45-degree field of view; fundus photo; 2212x1659px
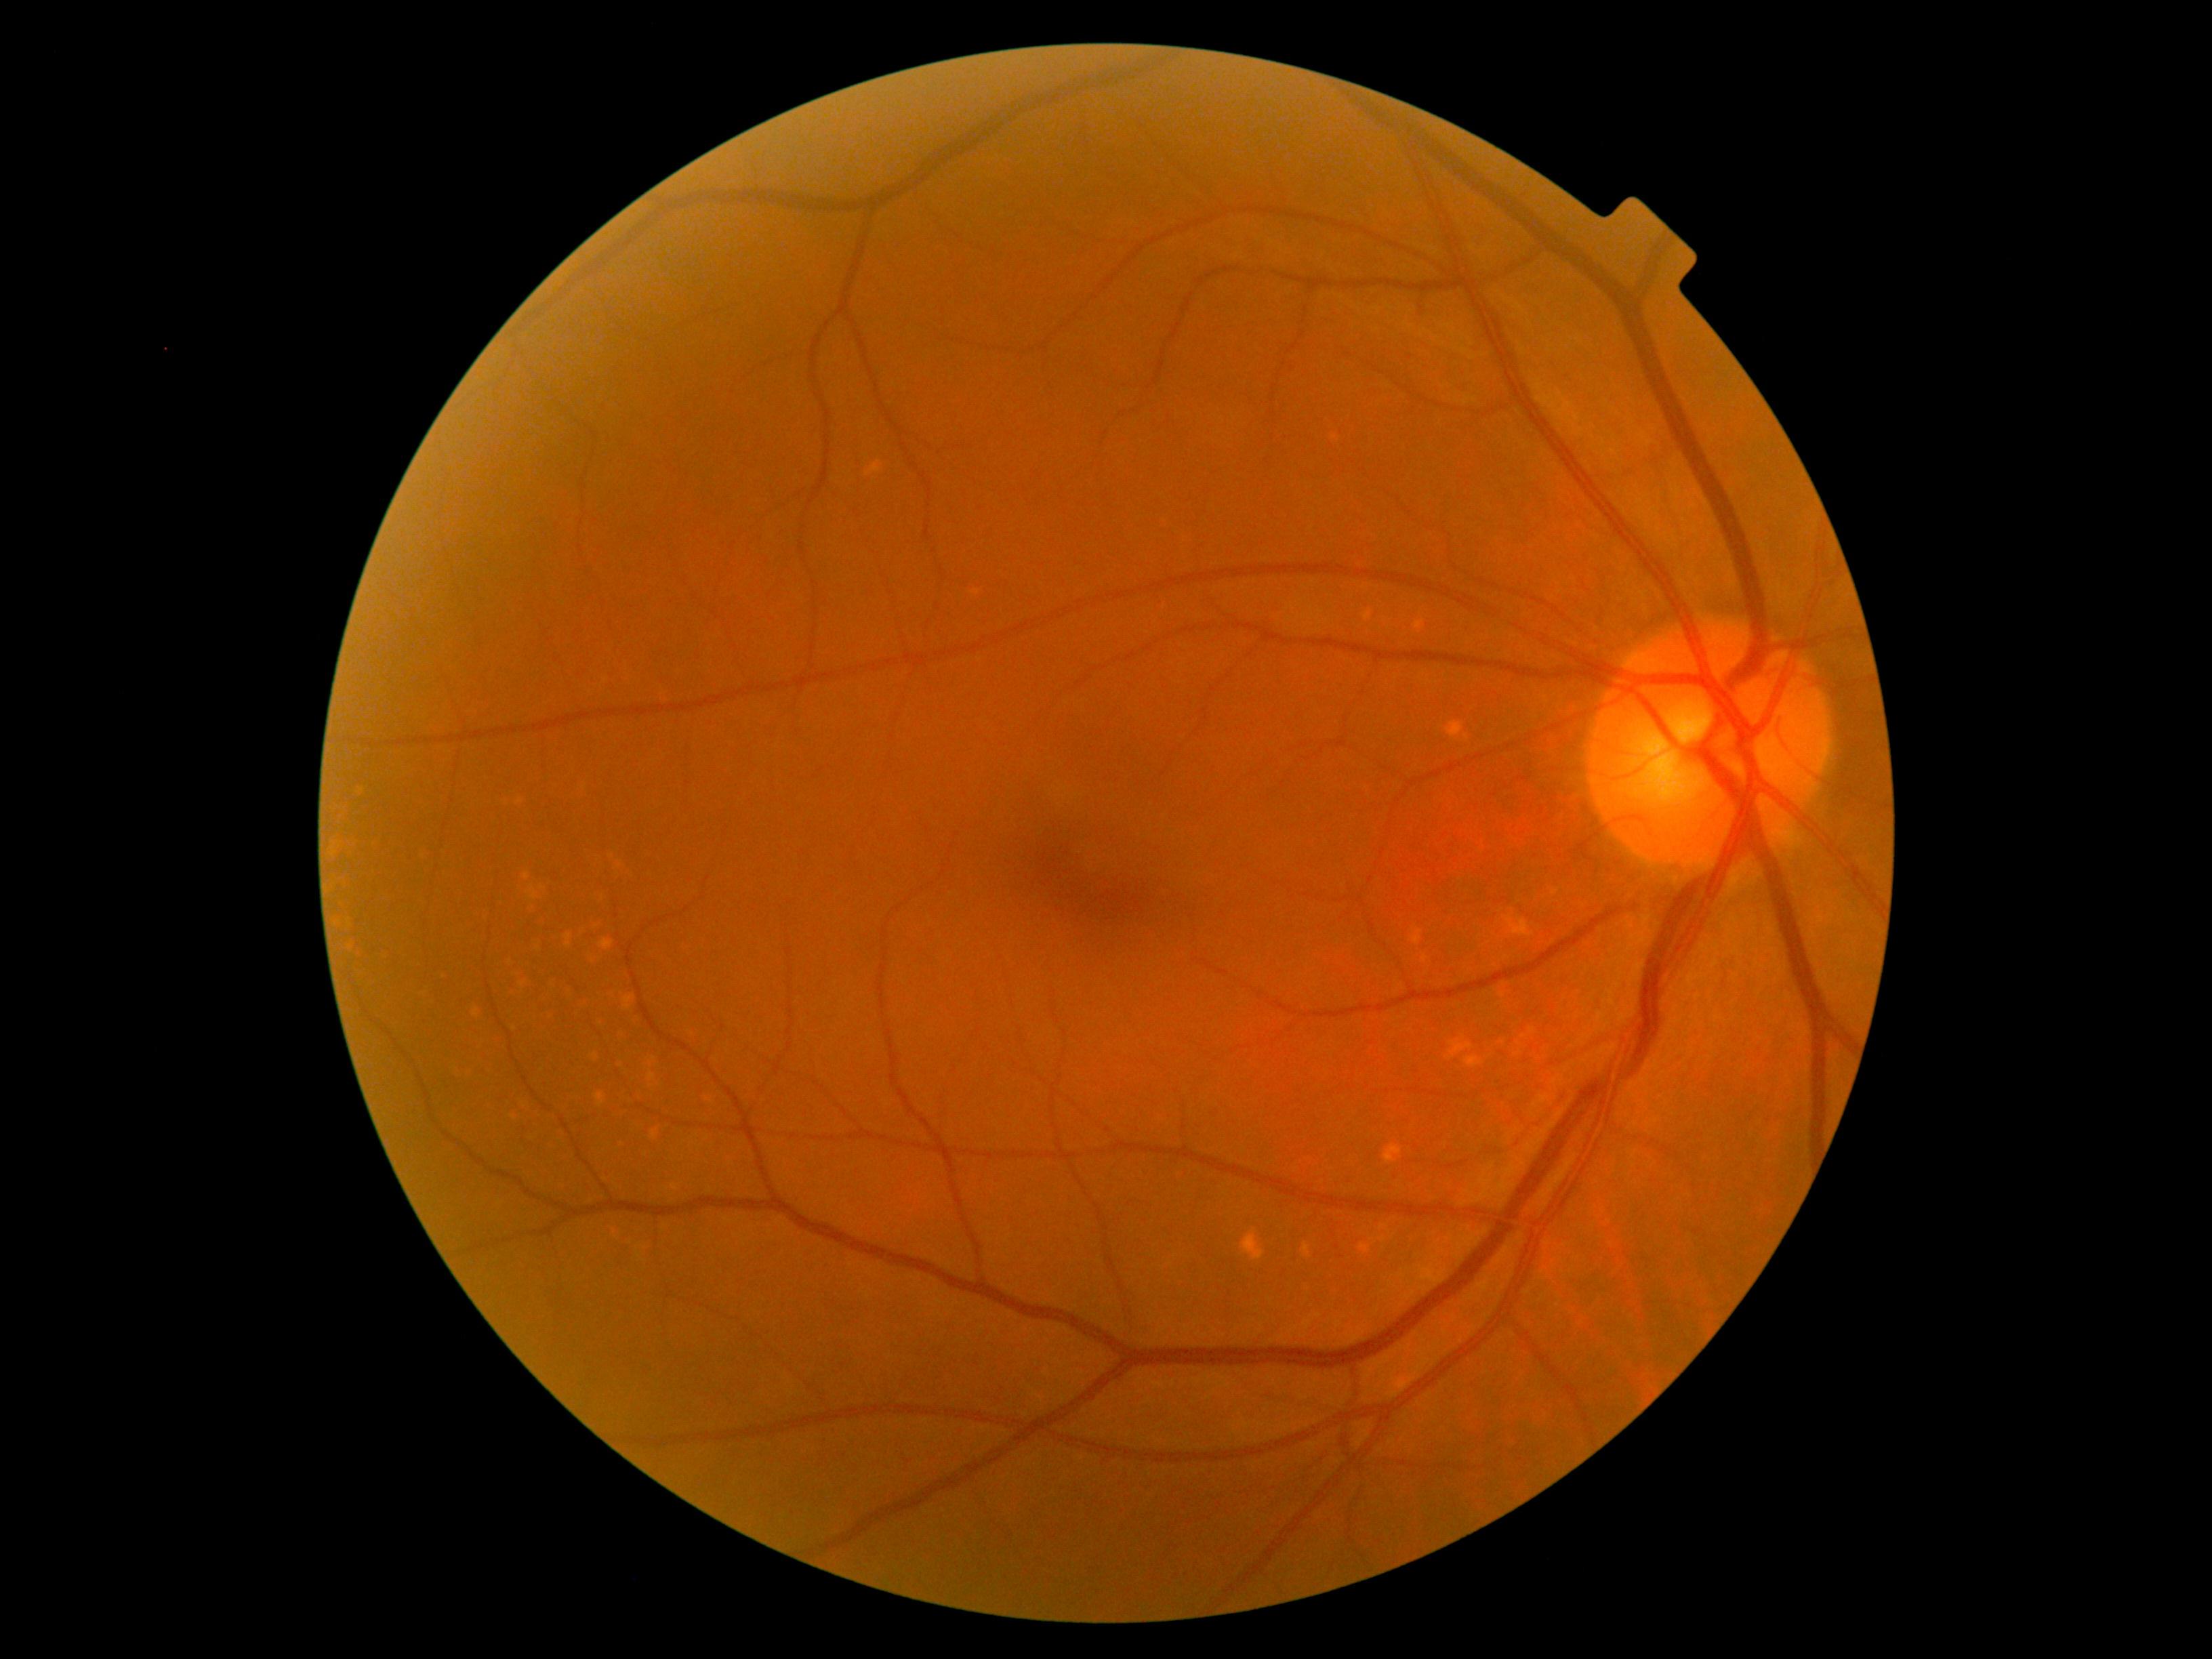
DR severity is grade 0 (no apparent retinopathy).